Infant wide-field retinal image.
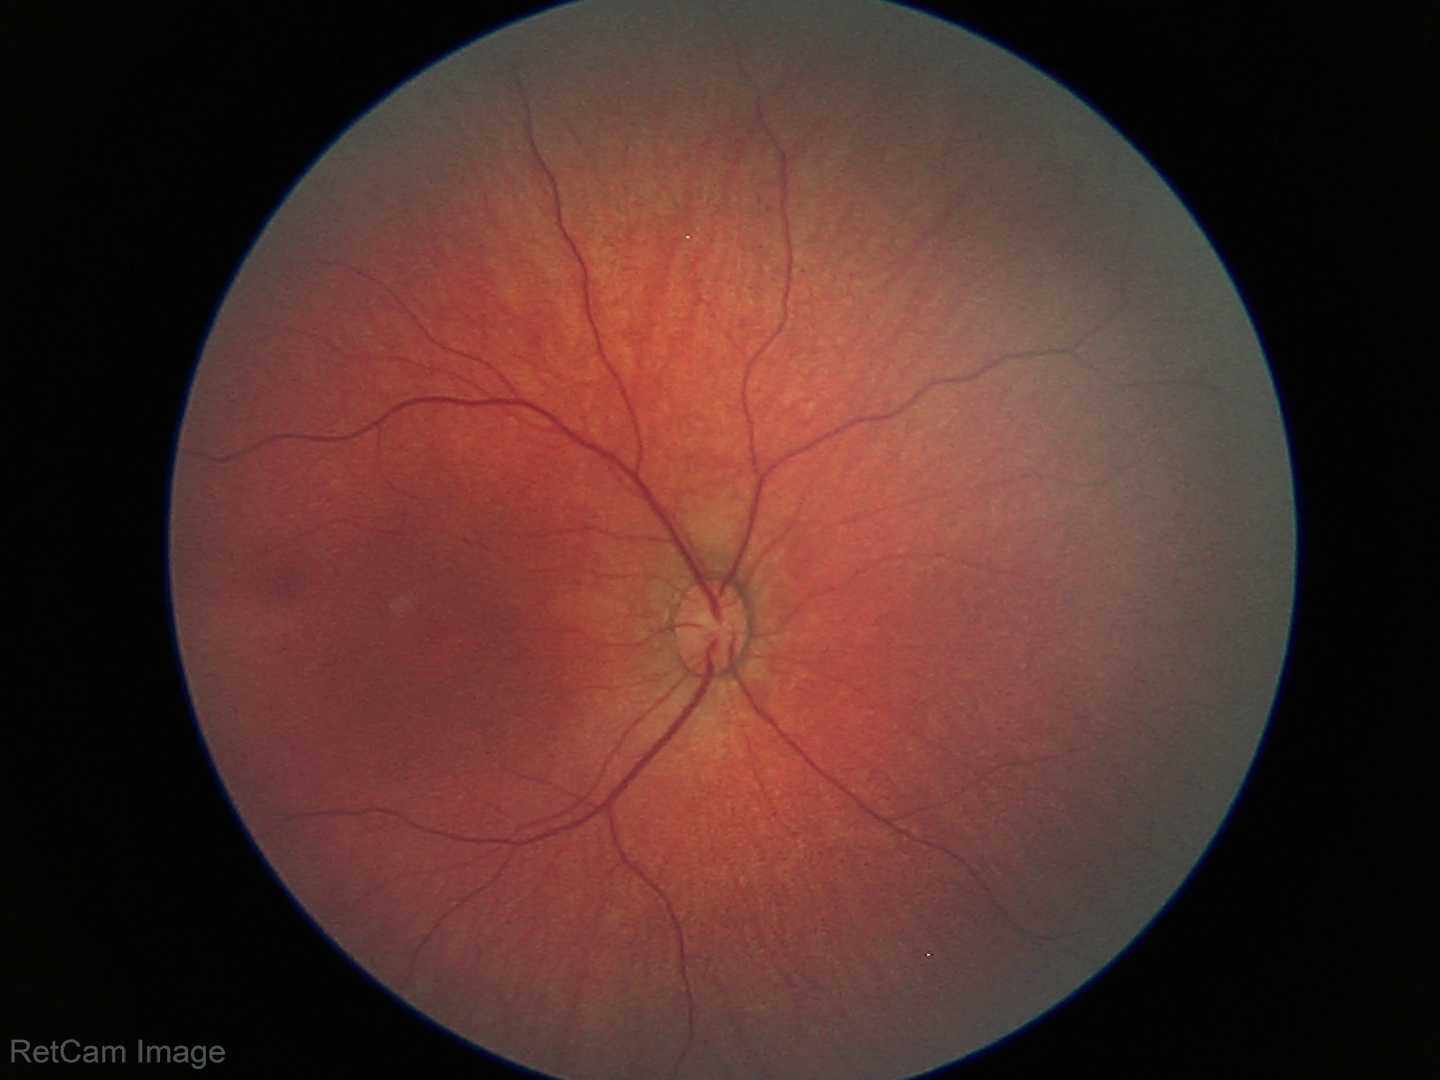 Screening examination diagnosed as physiological.